2352x1568px · color fundus photograph.
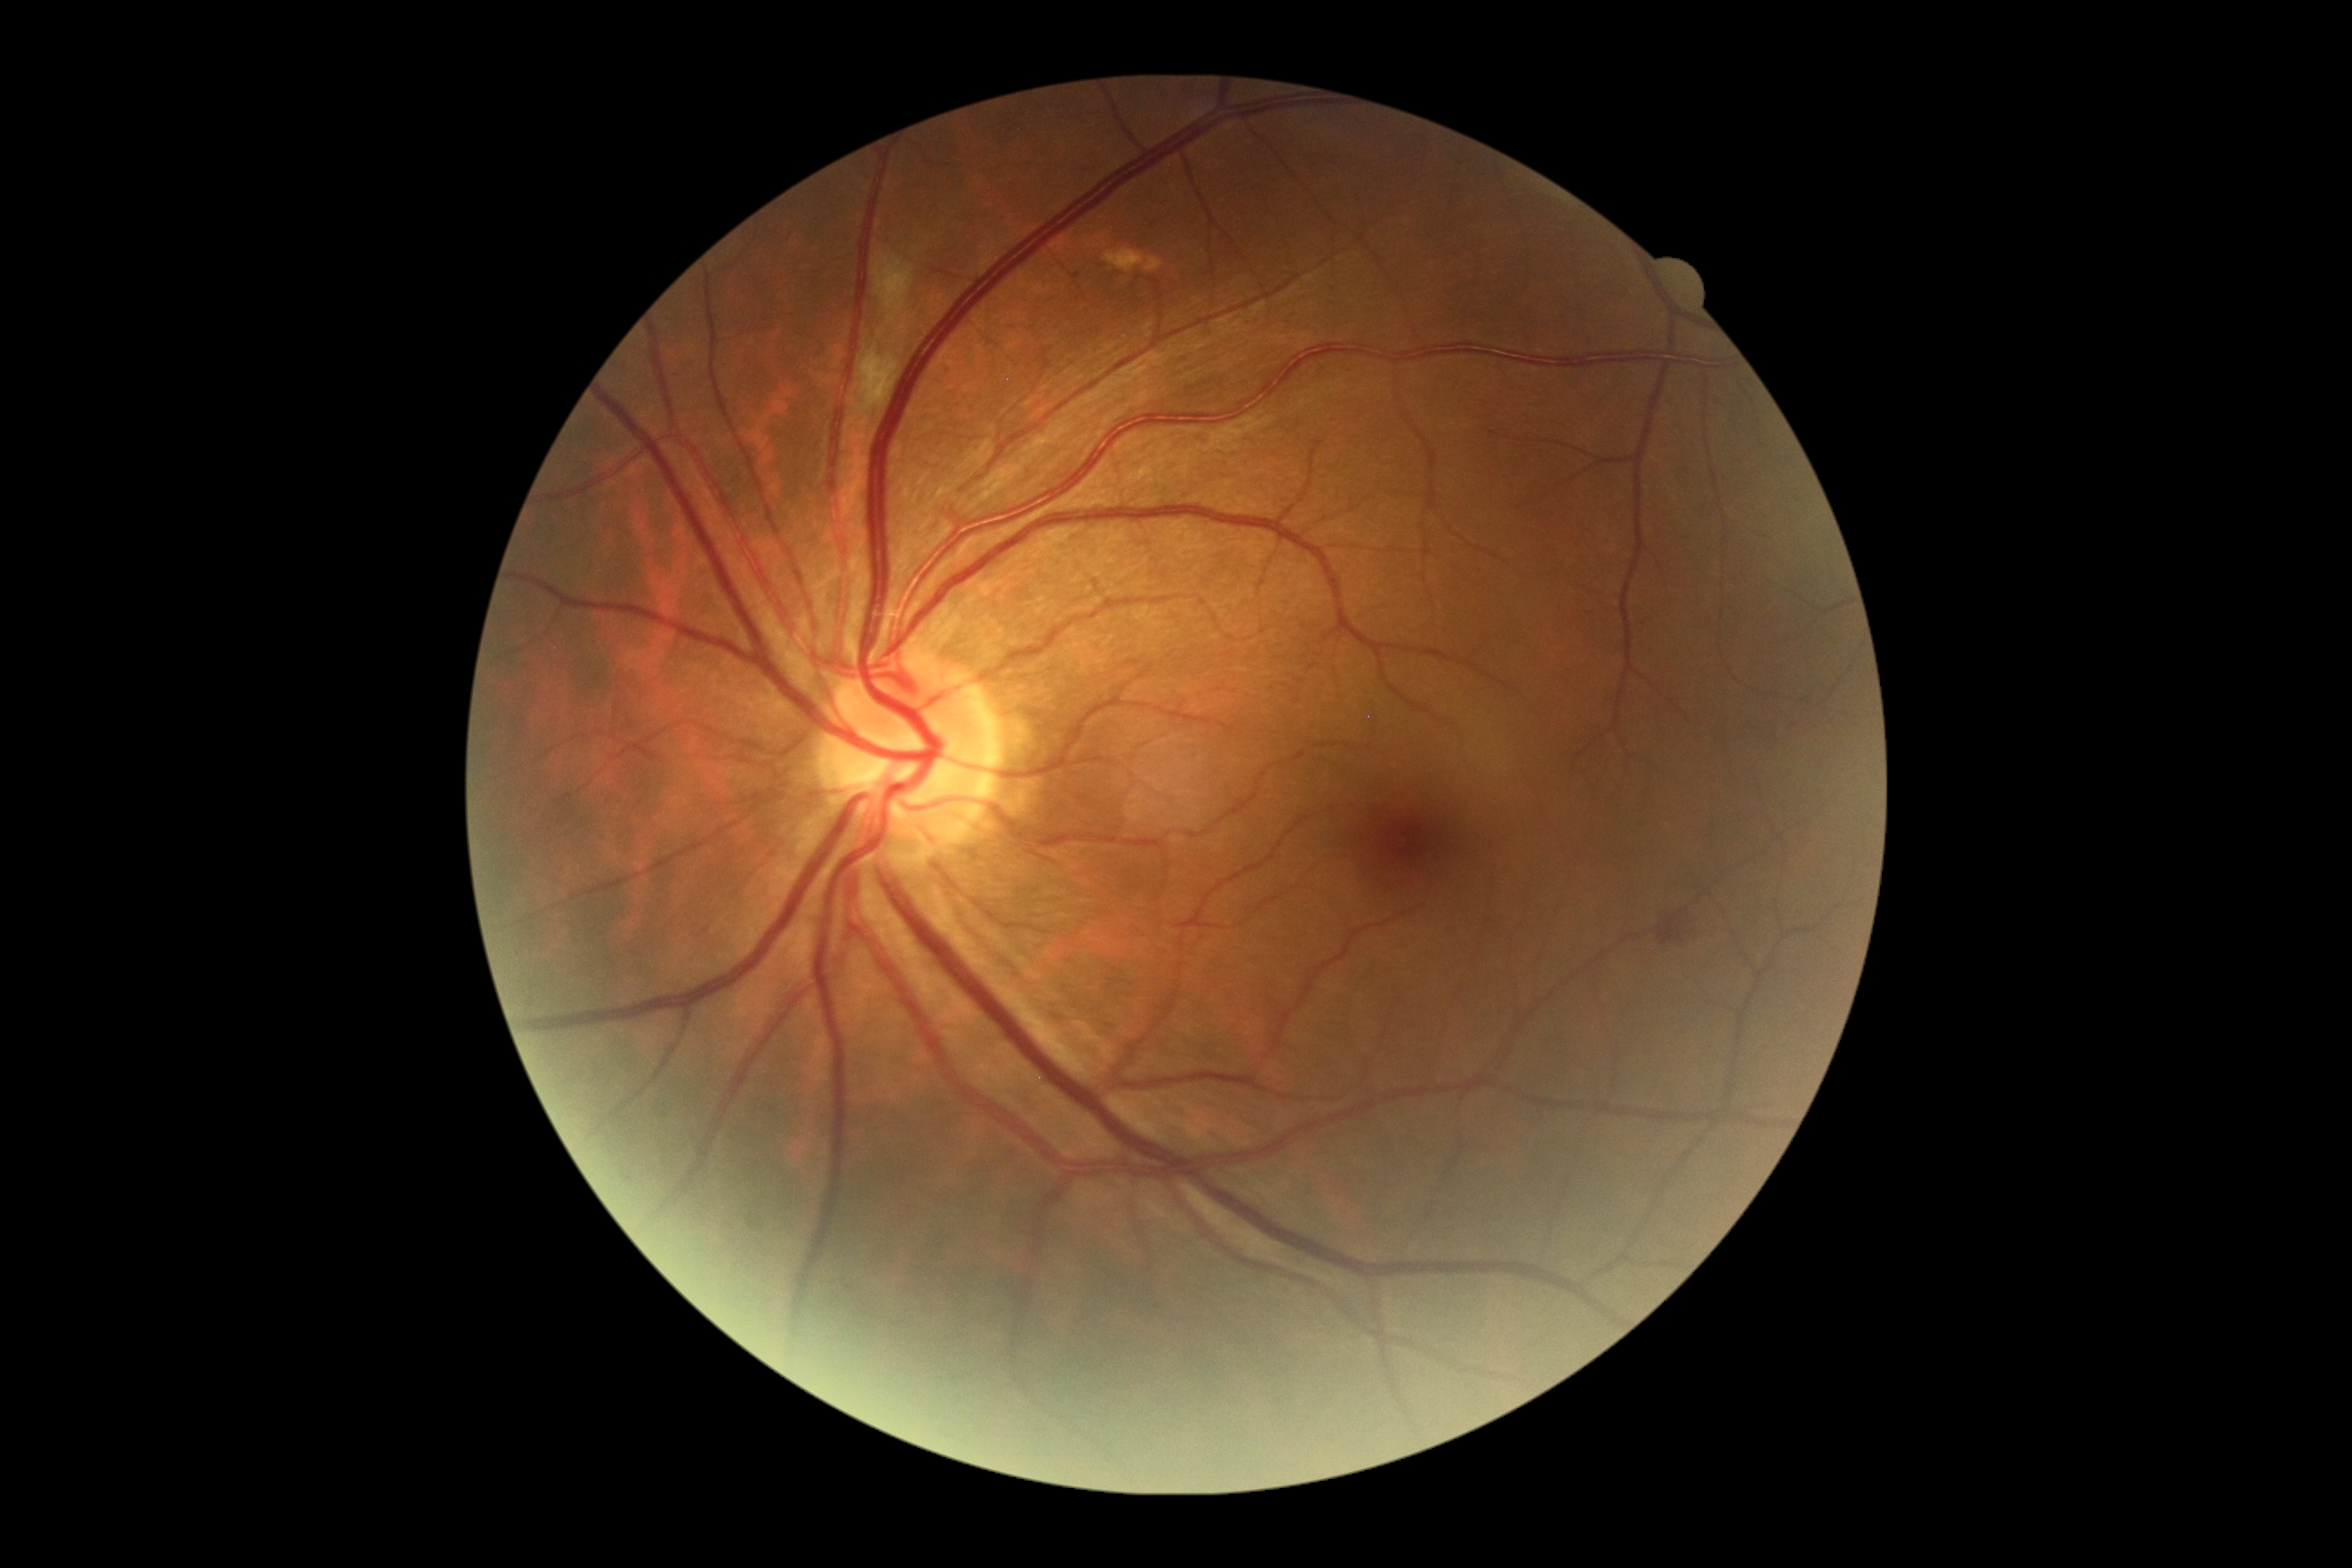
DR stage: grade 2 (moderate NPDR) — more than just microaneurysms but less than severe NPDR.